Retinal fundus photograph, acquired with a Remidio Fundus on Phone:
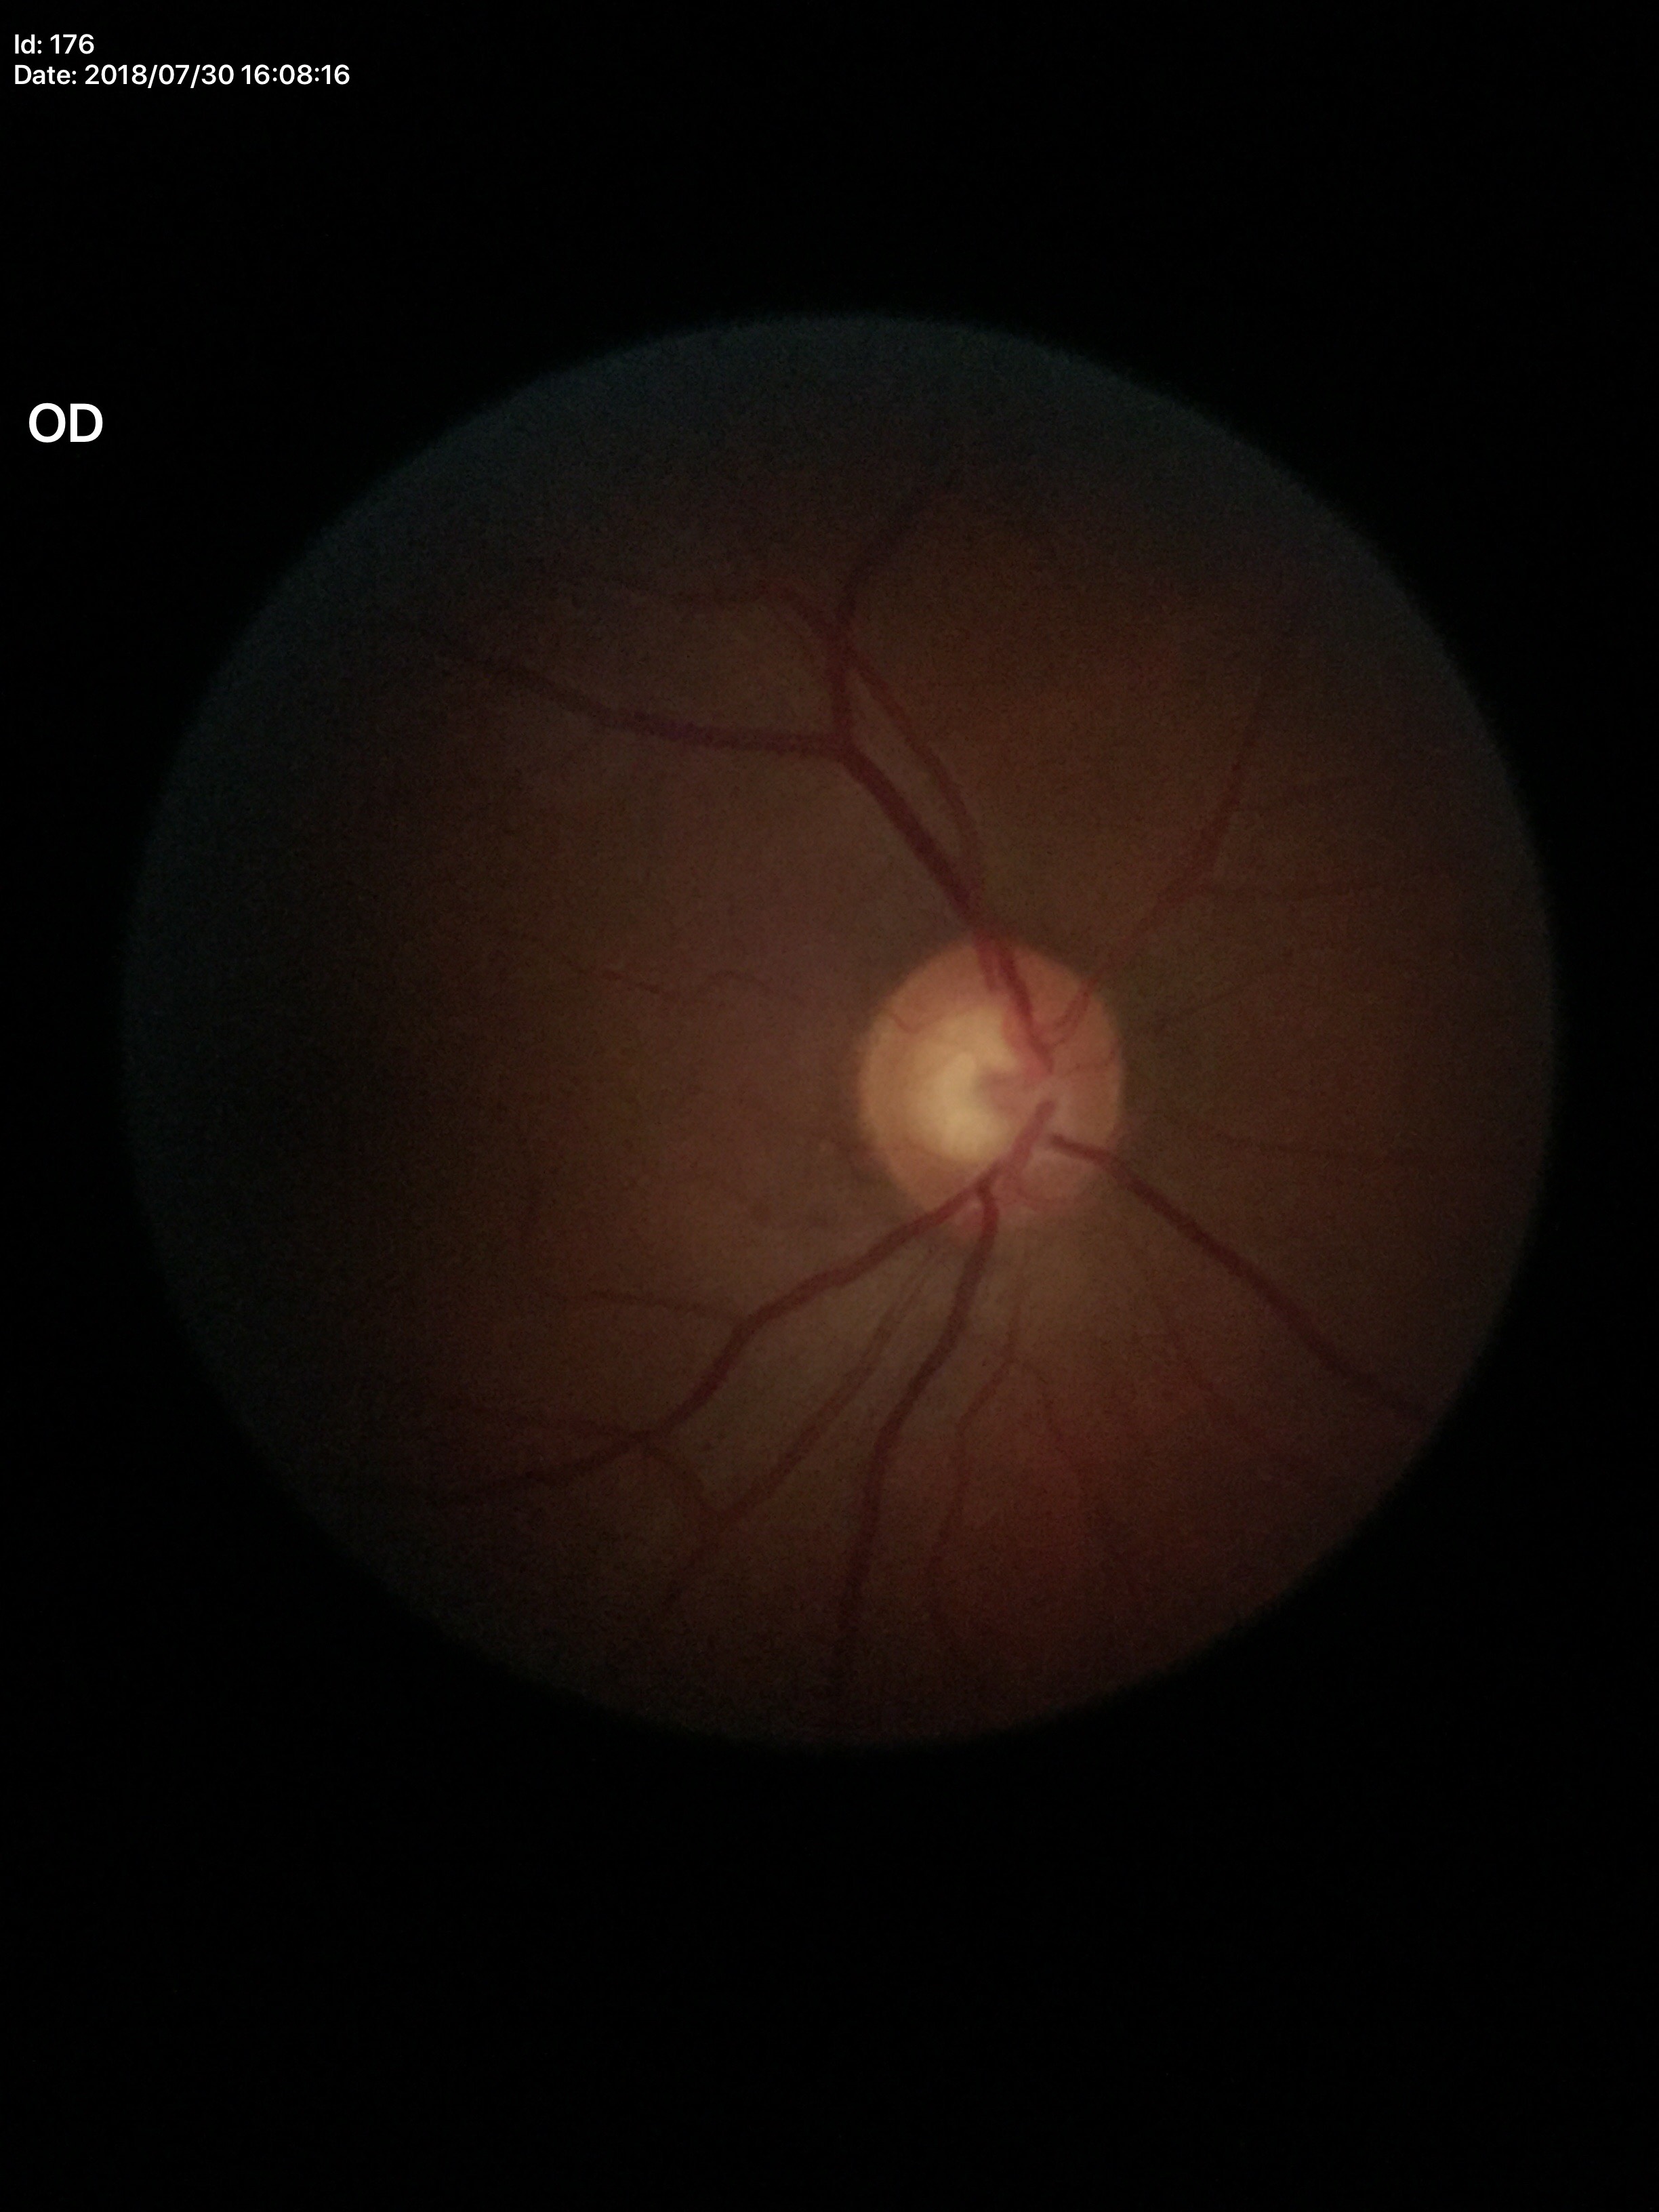 Vertical cup-disc ratio of 0.60. Not suspicious for glaucoma. Horizontal cup-disc ratio of 0.61.